Modified Davis classification.
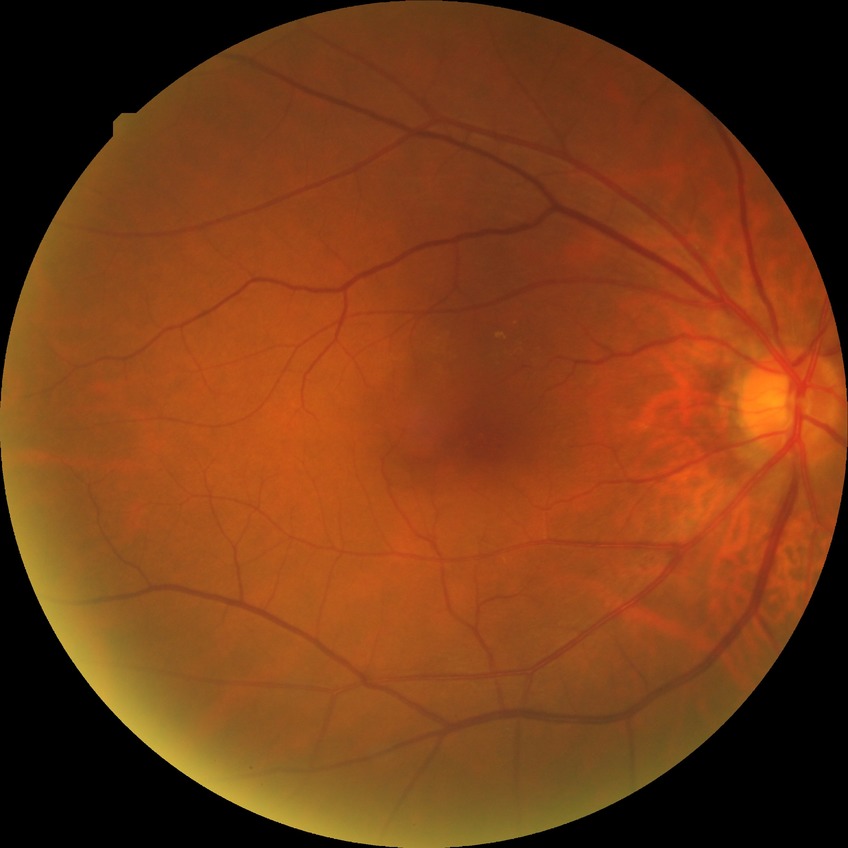
Diabetic retinopathy (DR) is NDR (no diabetic retinopathy).